Color fundus image.
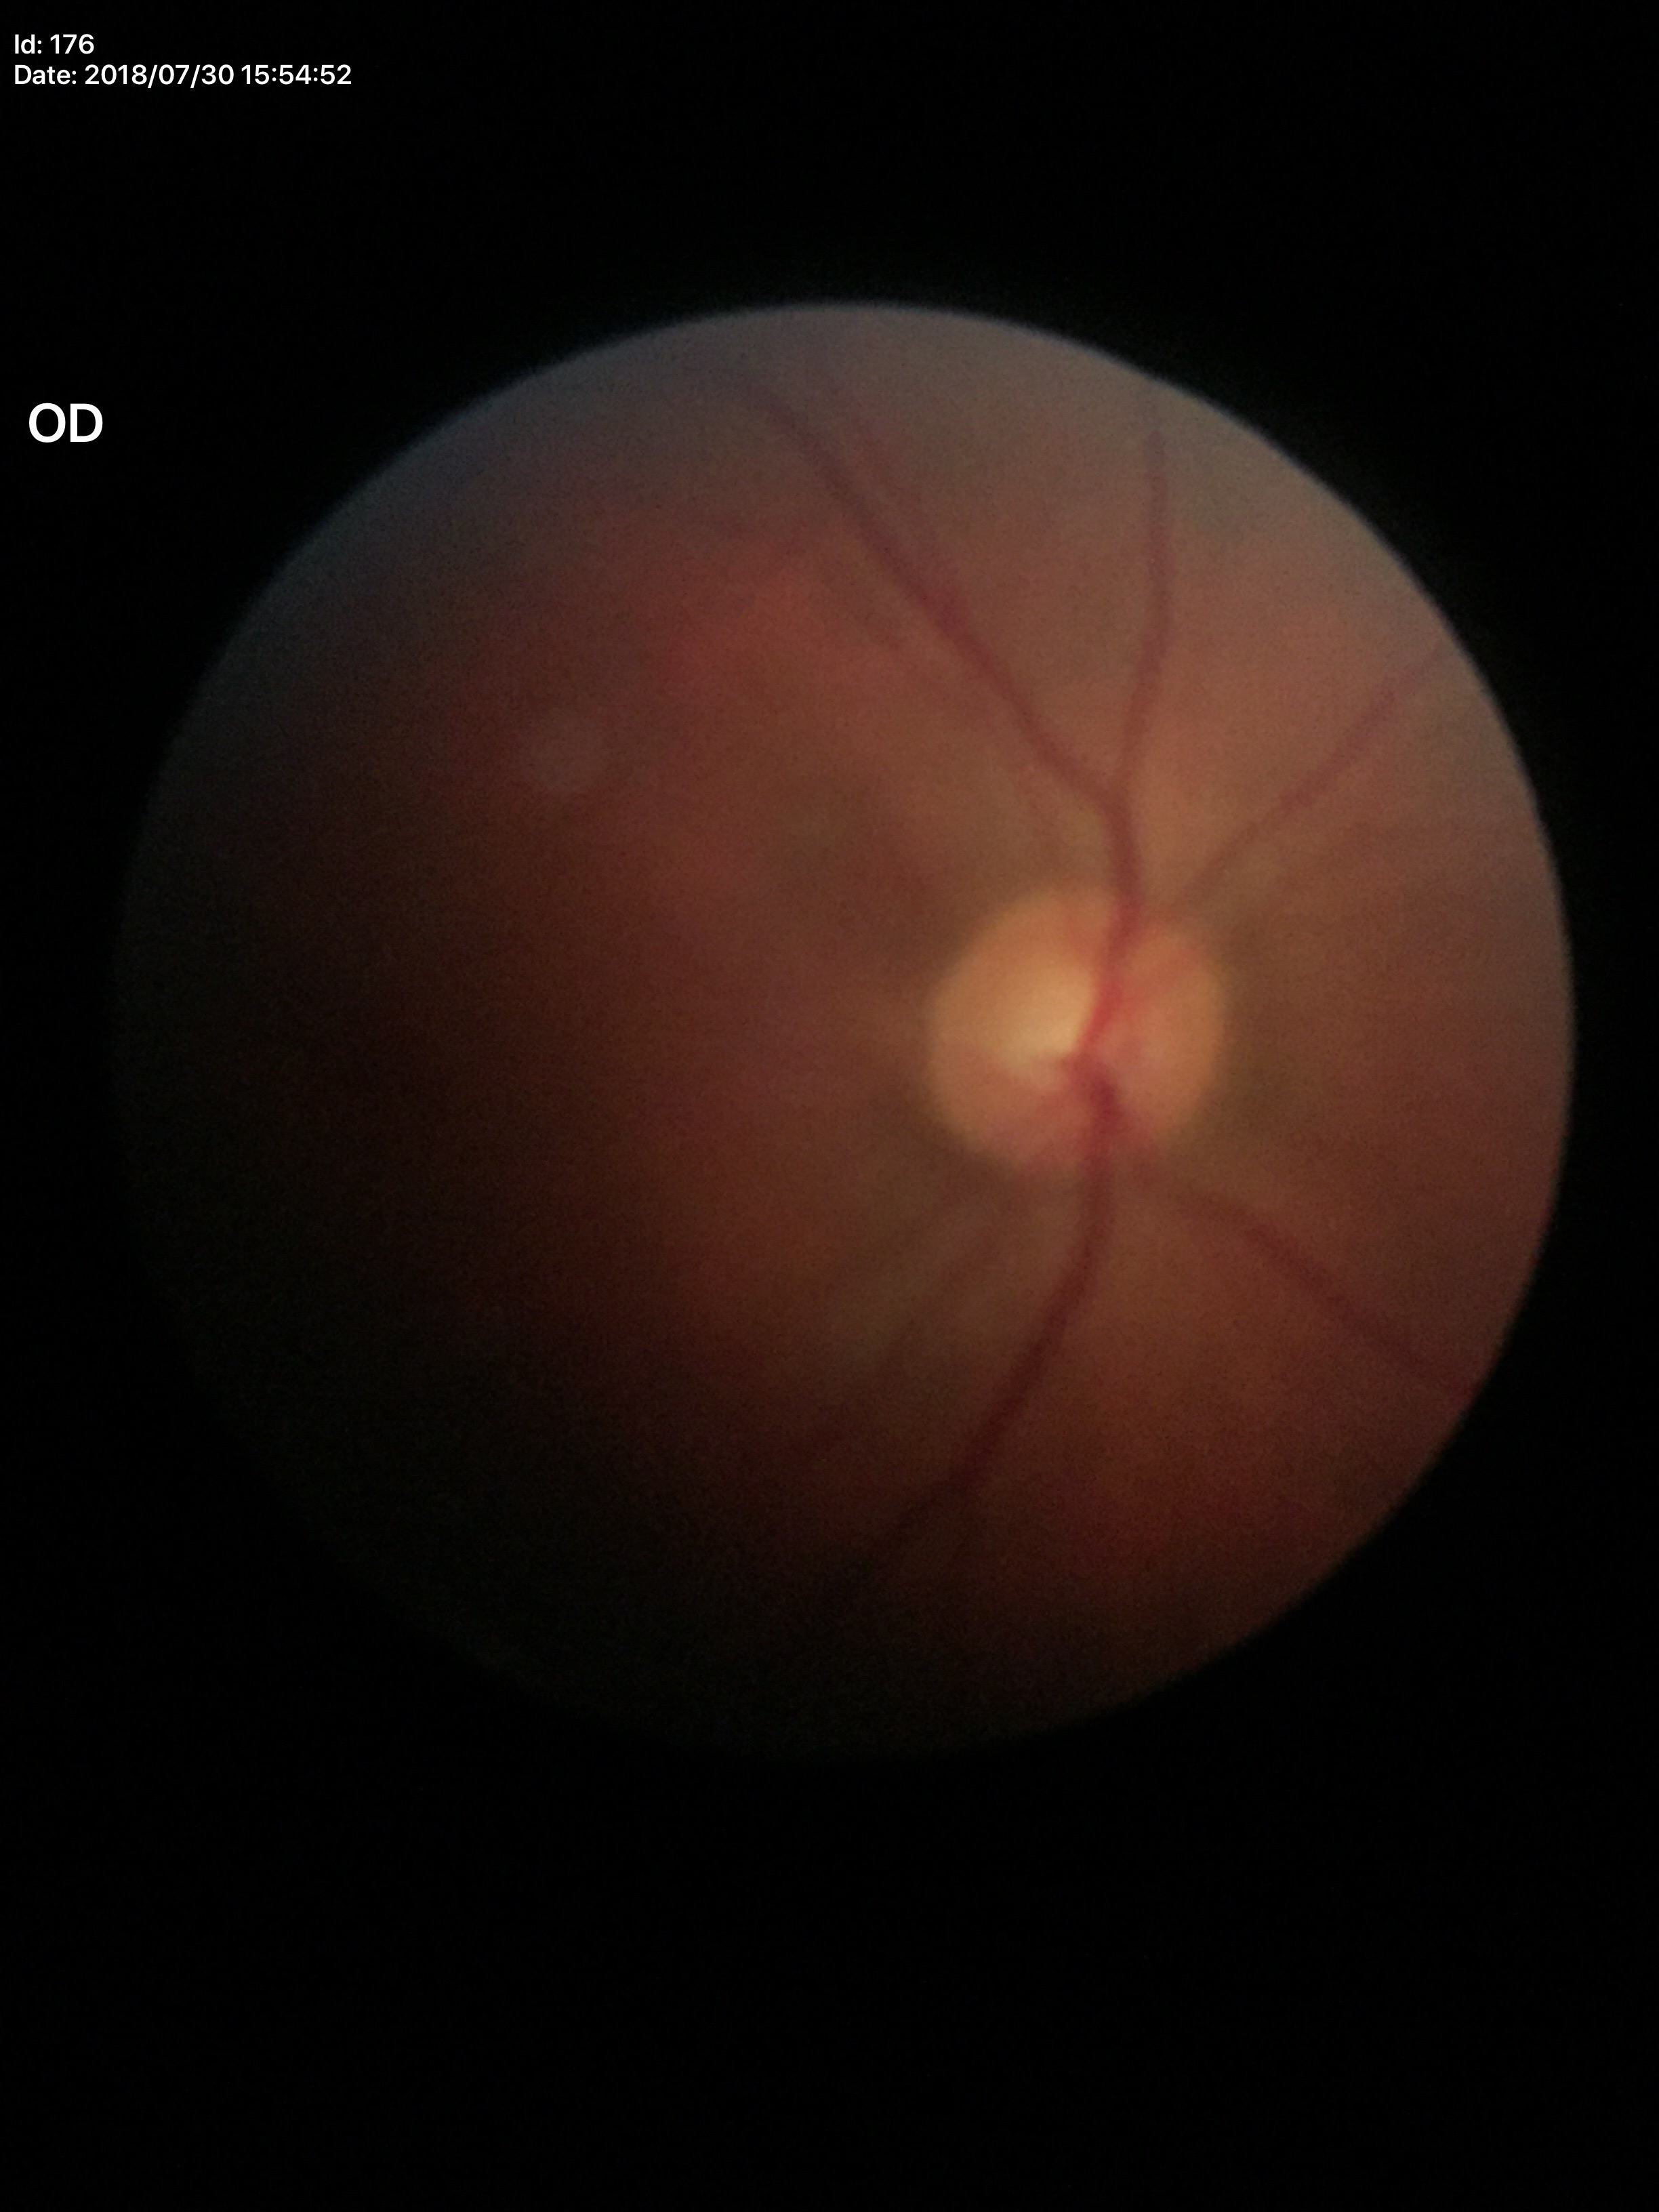

Glaucoma impression: no suspicious findings (1 of 5 graders flagged glaucoma suspect).
ACDR: 0.29.
VCDR: 0.53.